Retinal fundus photograph: 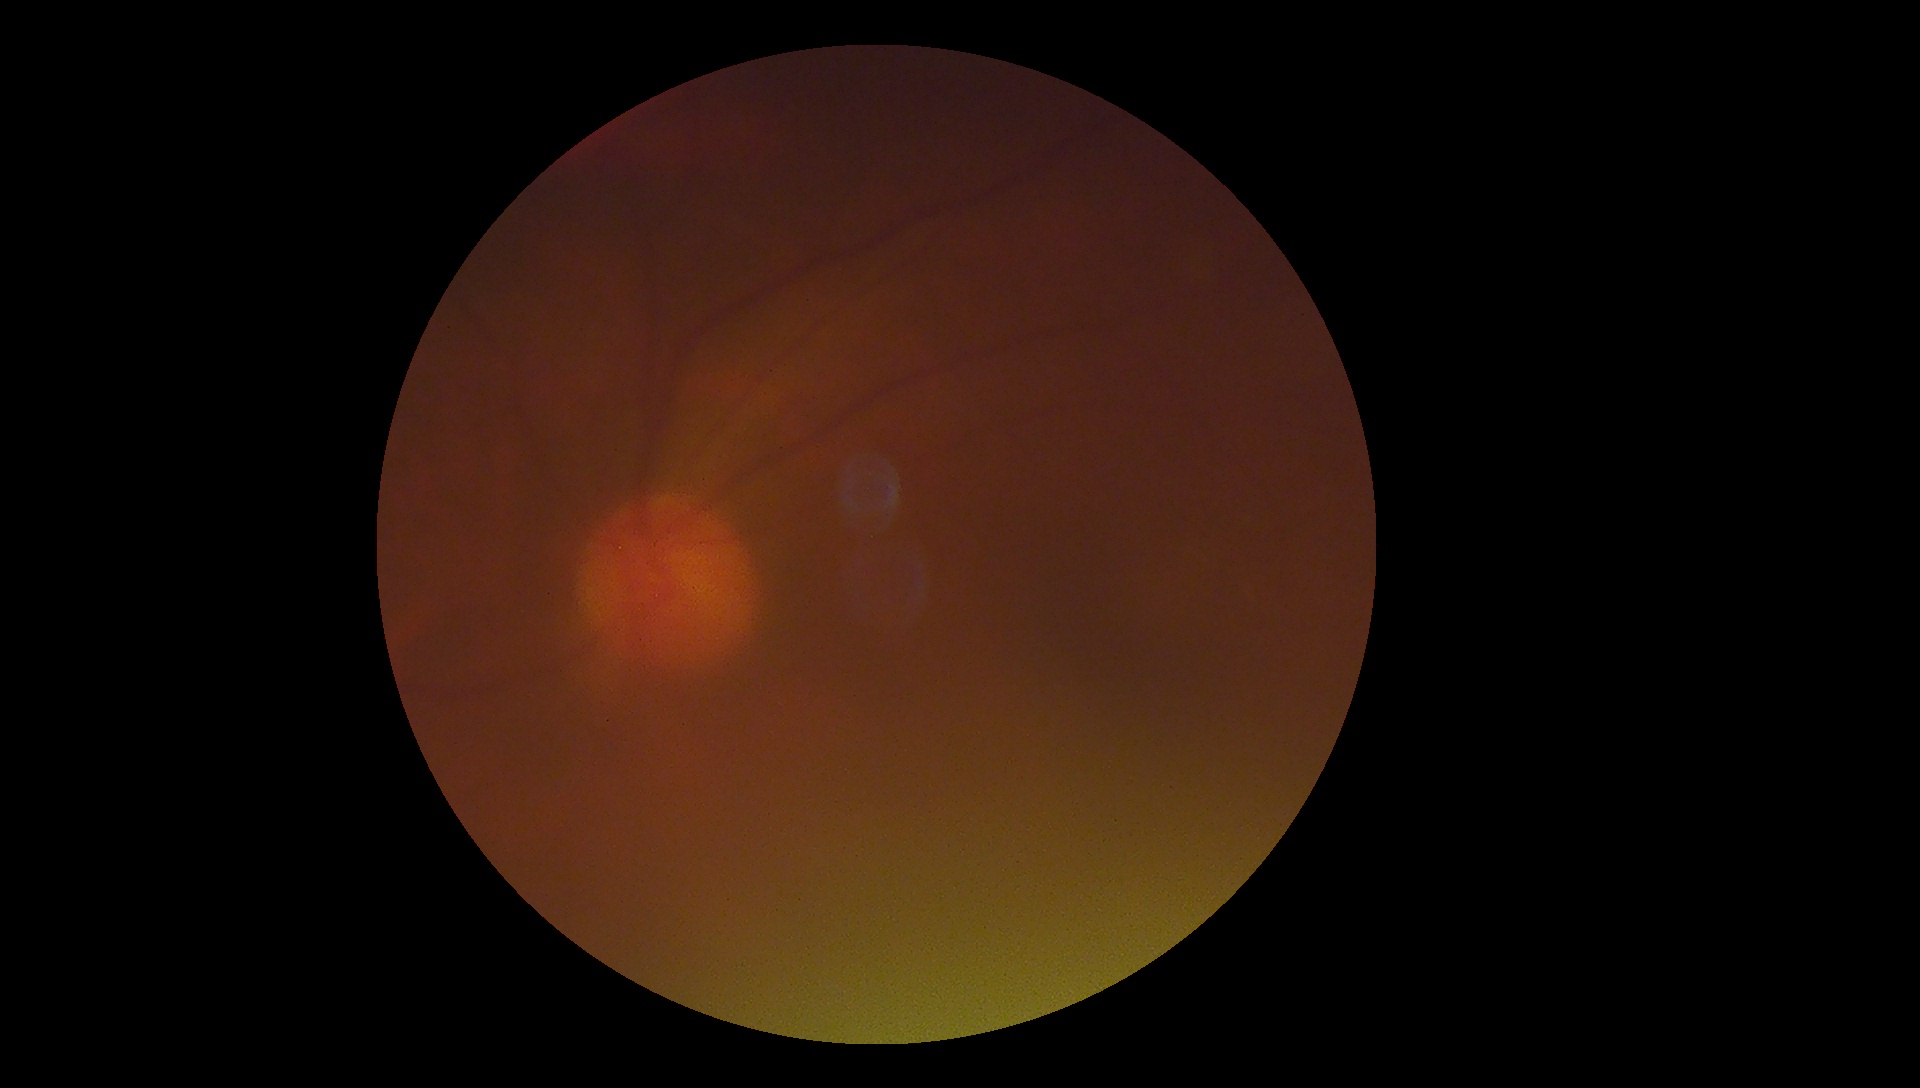

* diabetic retinopathy (DR) — ungradable